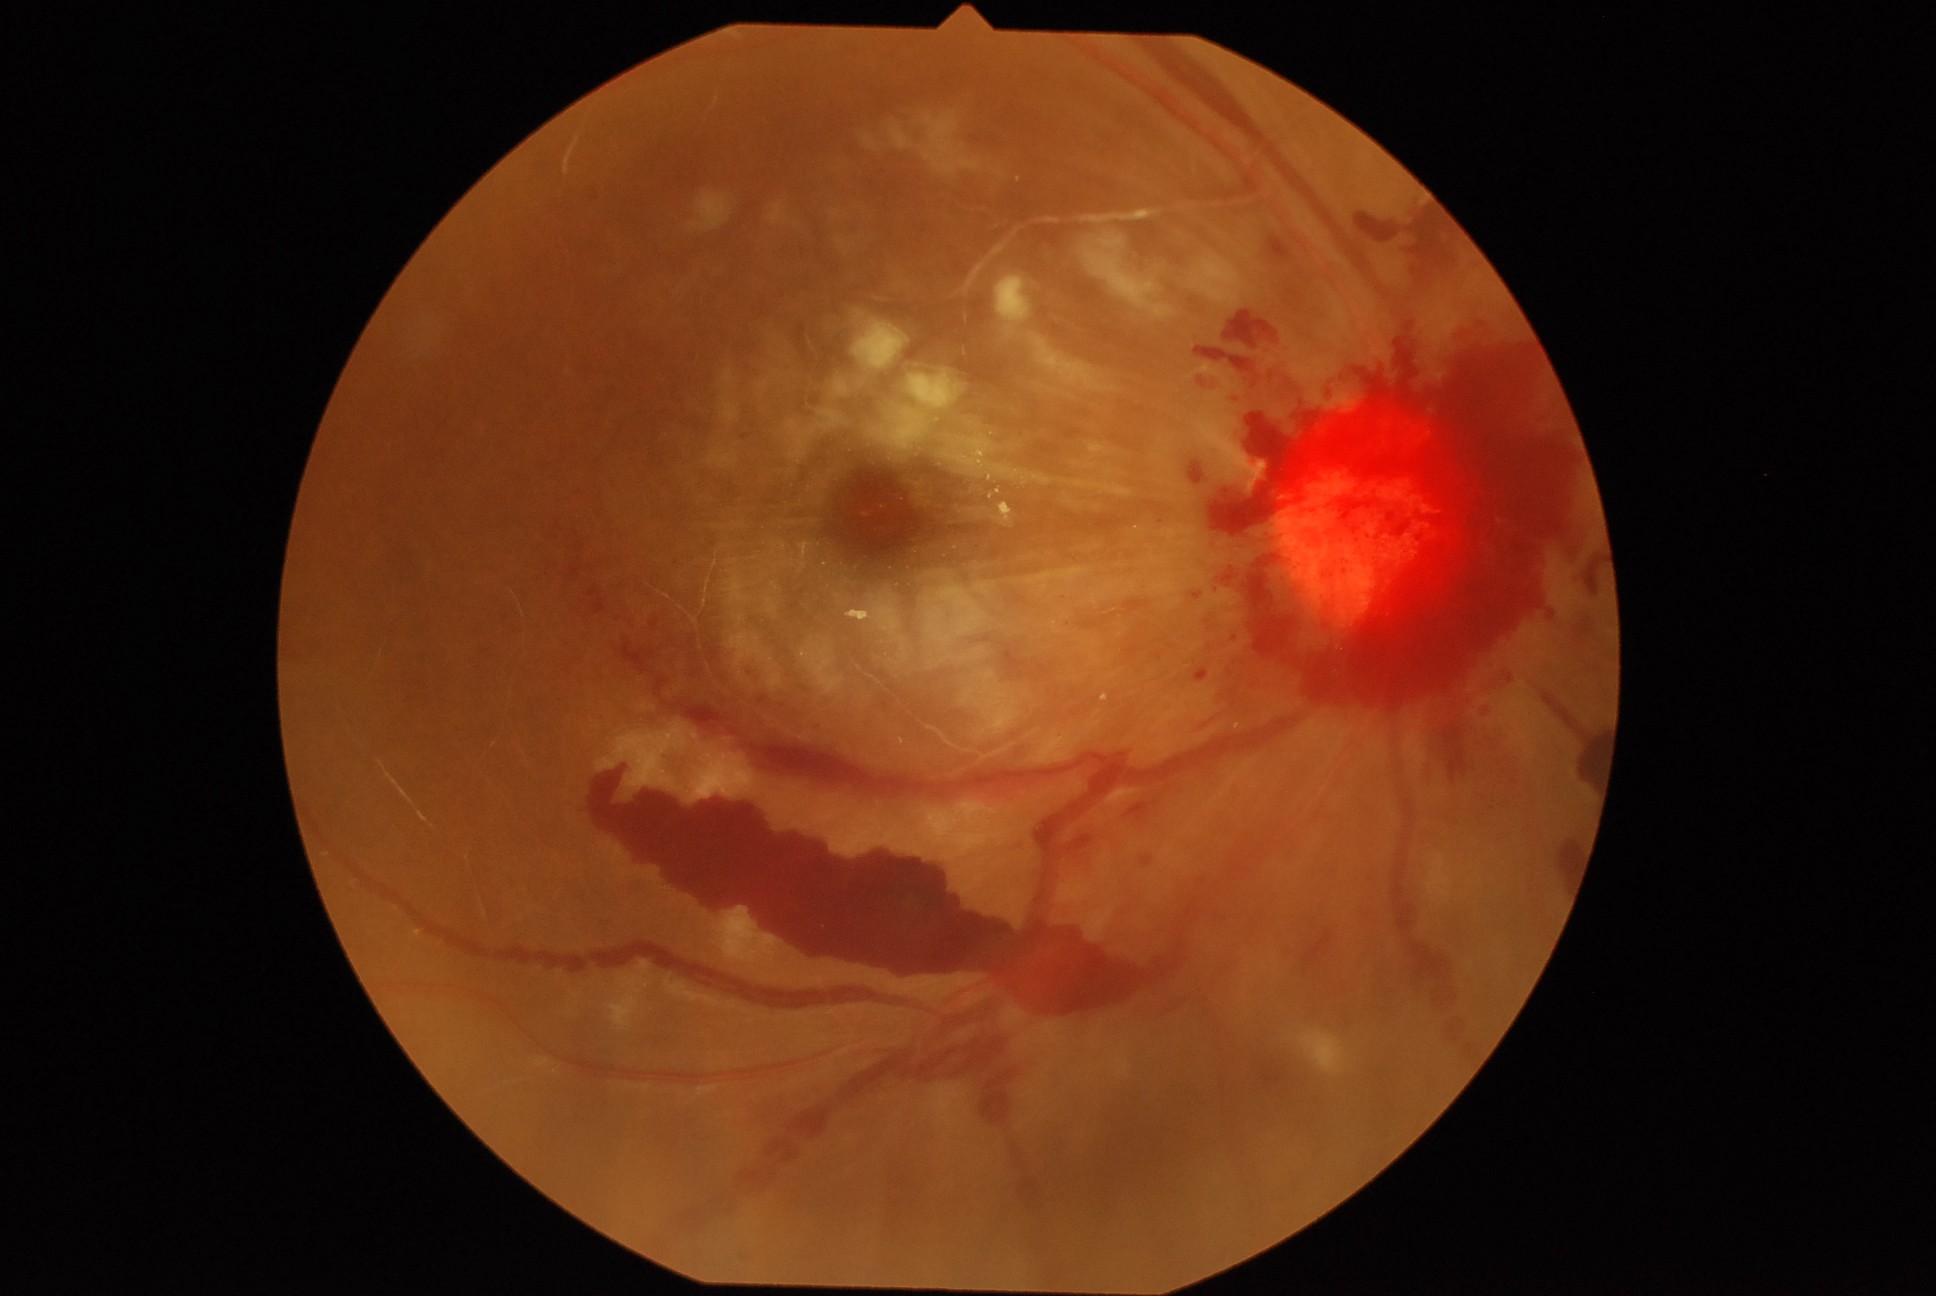
– DR class: proliferative diabetic retinopathy
– diabetic retinopathy severity: proliferative diabetic retinopathy (grade 4)